Wide-field fundus photograph of an infant:
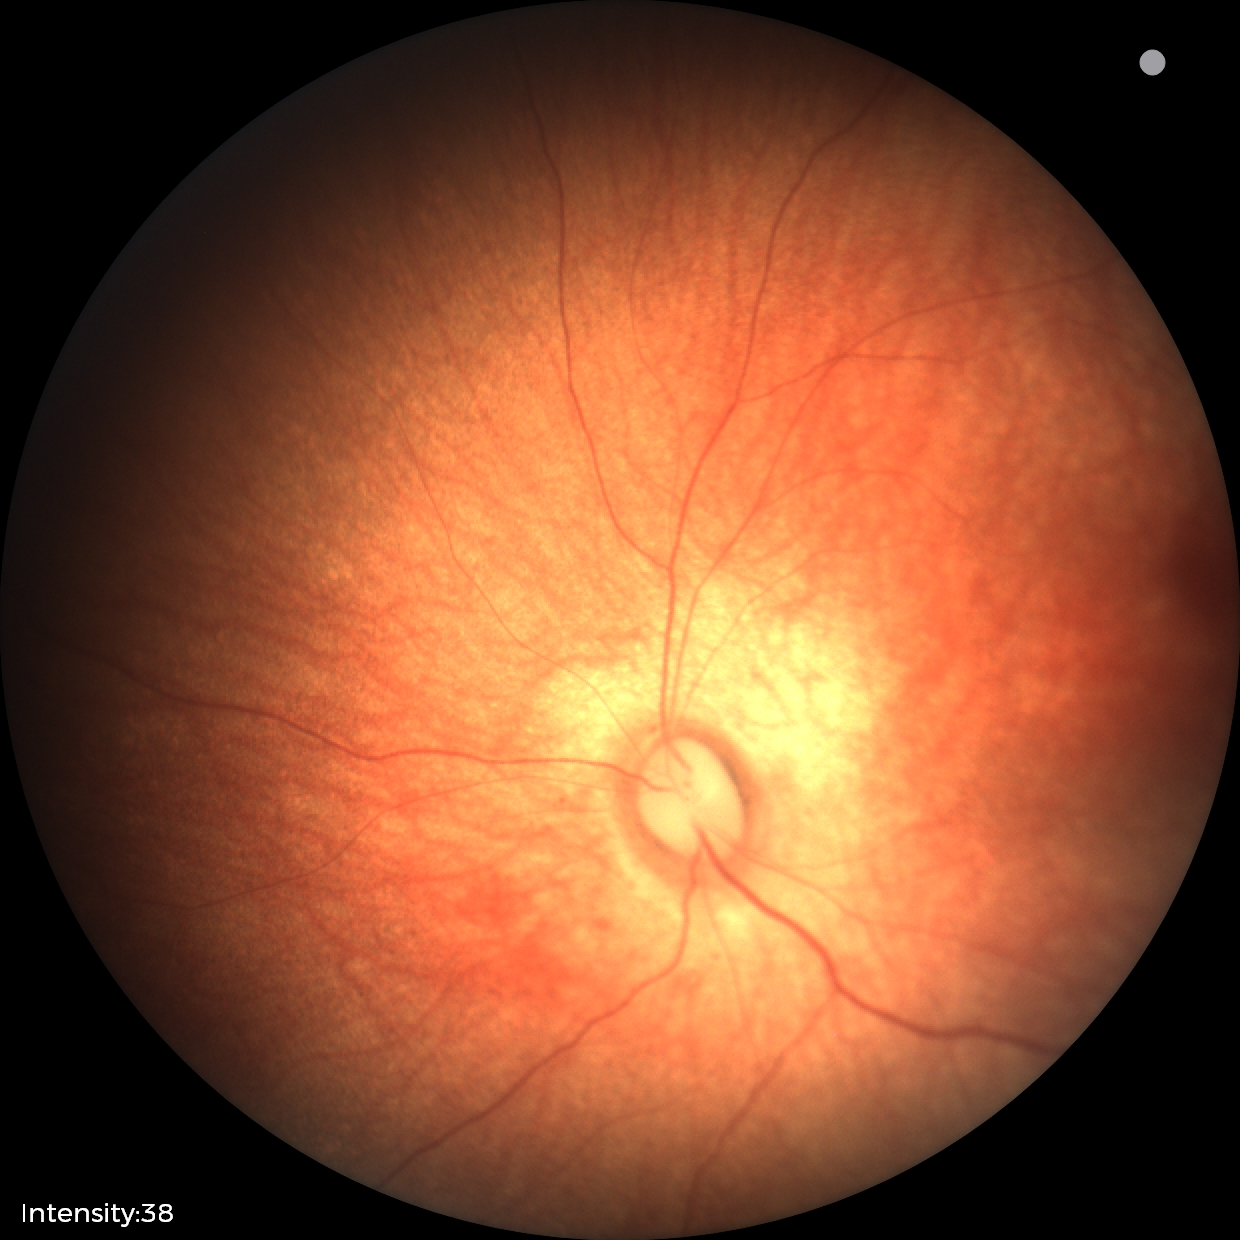

Examination with physiological retinal findings.